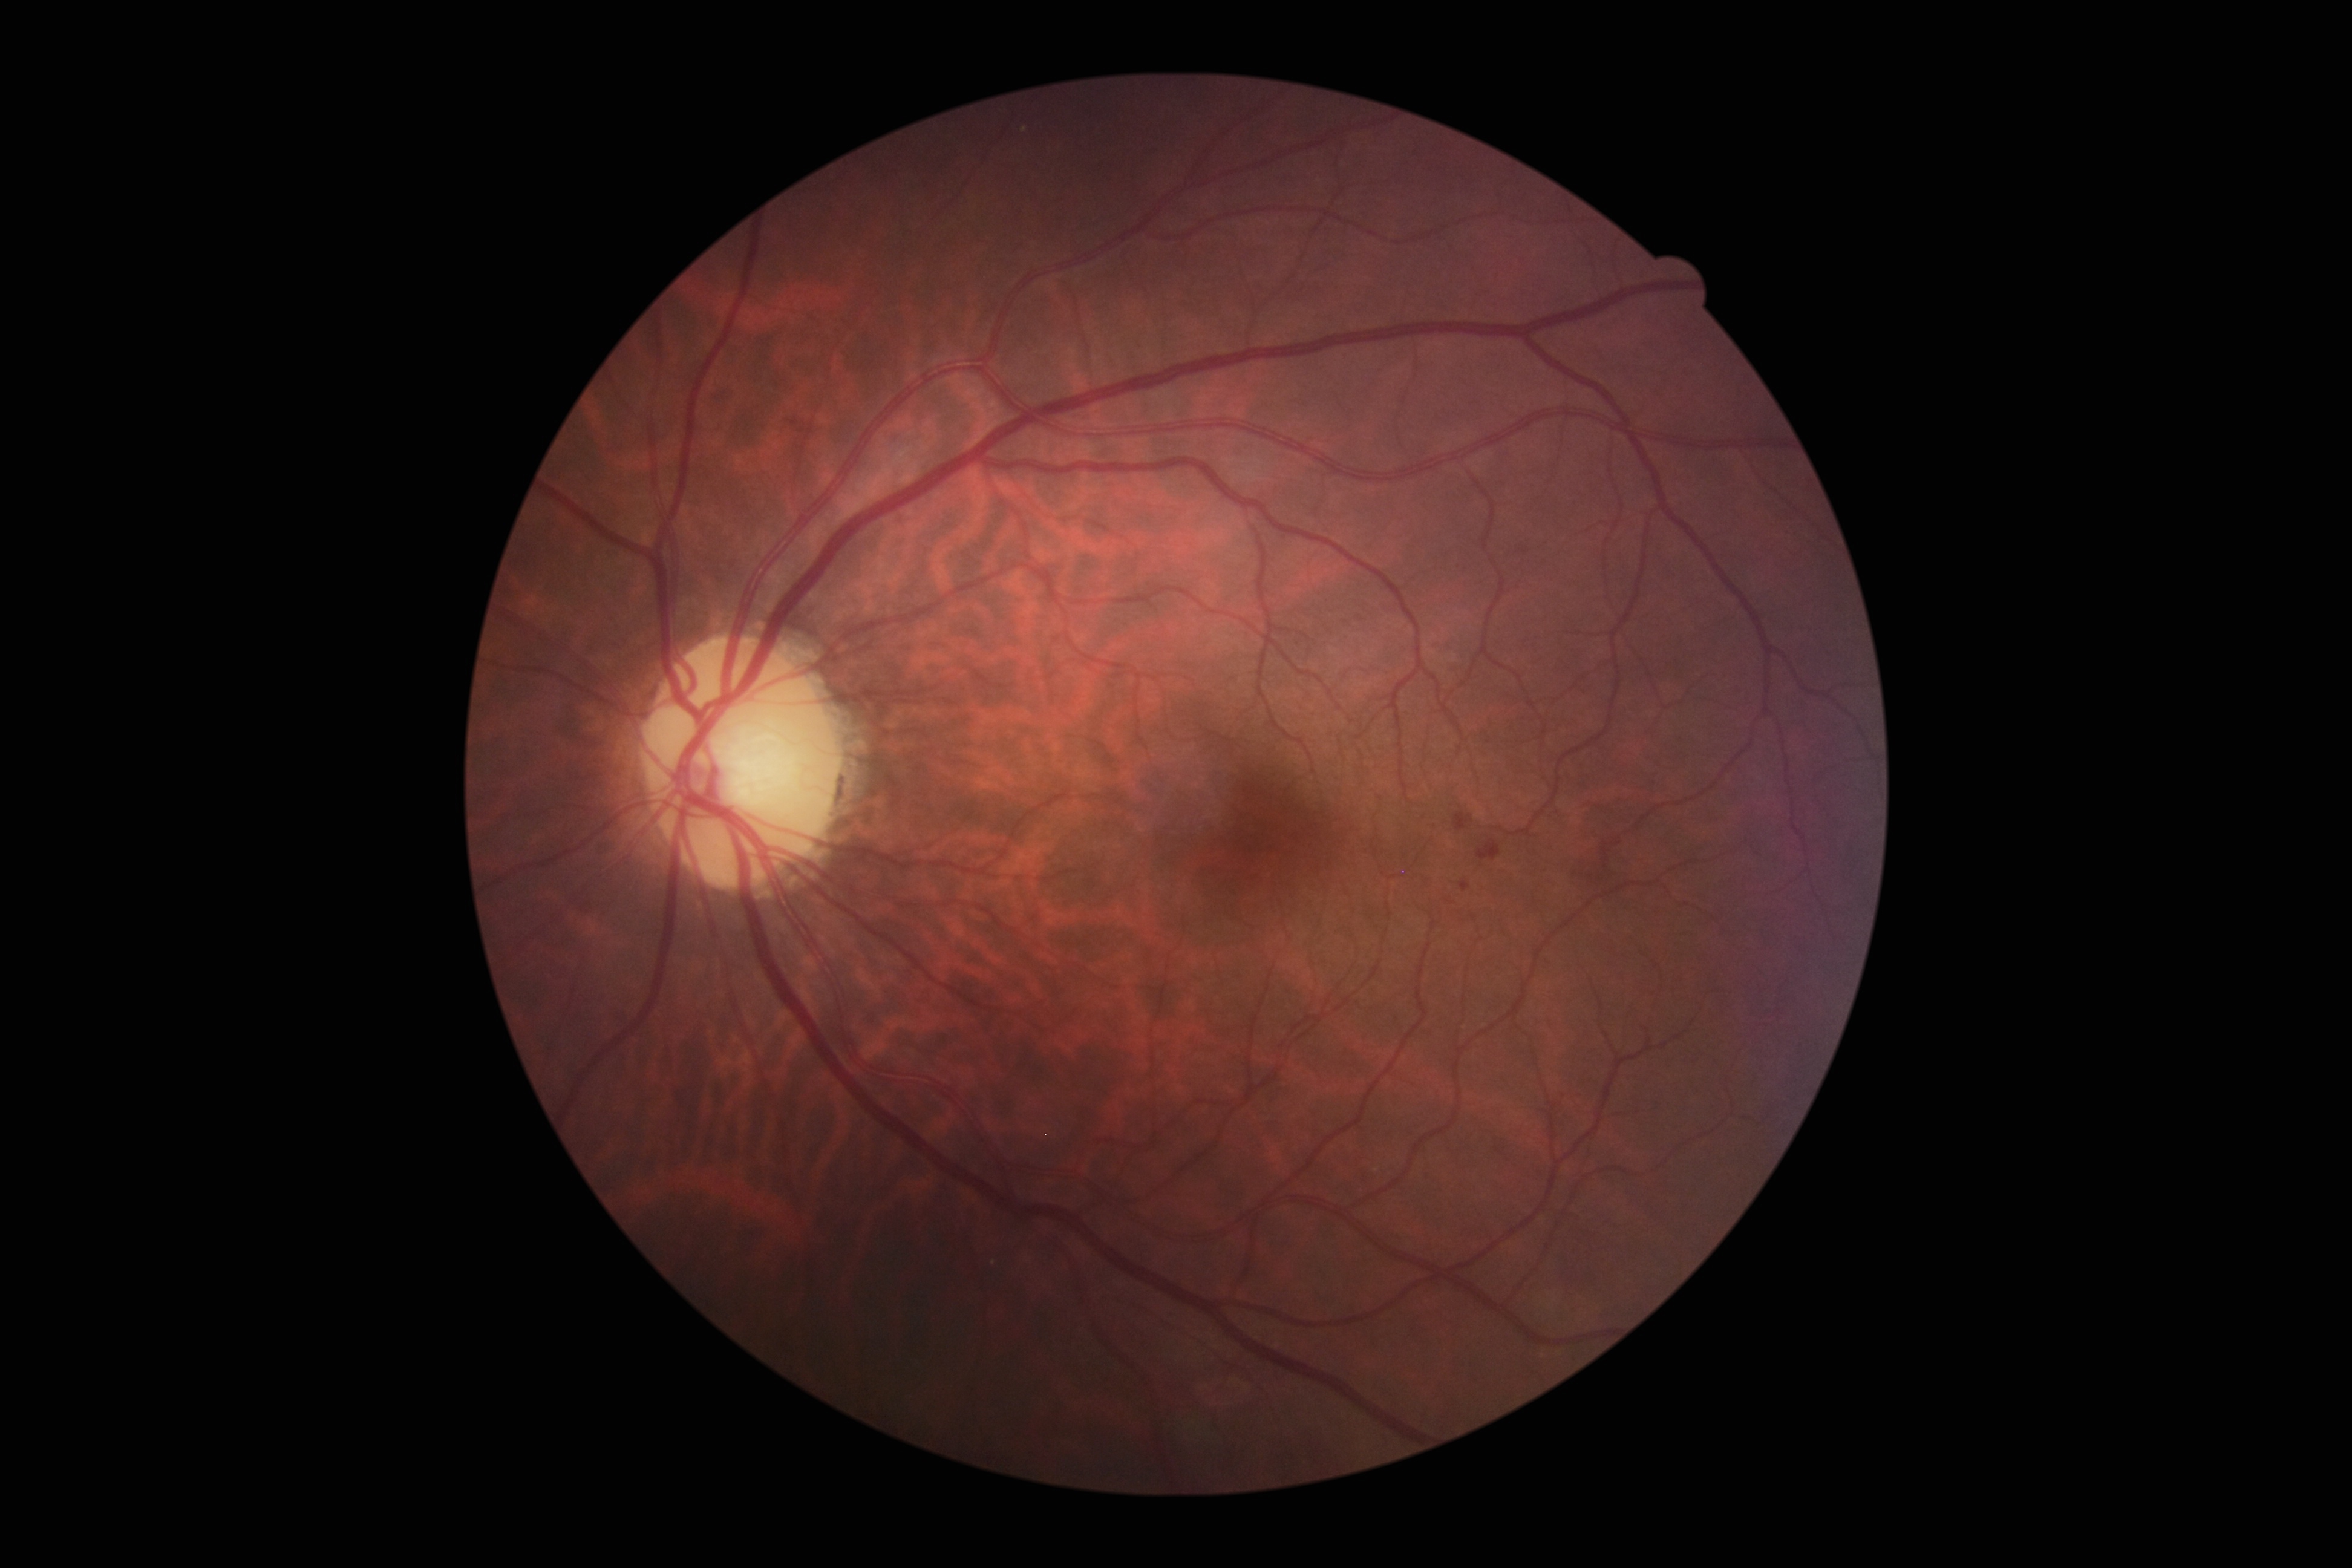

  dr_grade: 2 (moderate NPDR)
  dr_category: non-proliferative diabetic retinopathy